Fundus photo; 848x848; 45° field of view; camera: NIDEK AFC-230; diabetic retinopathy graded by the modified Davis classification; no pharmacologic dilation: 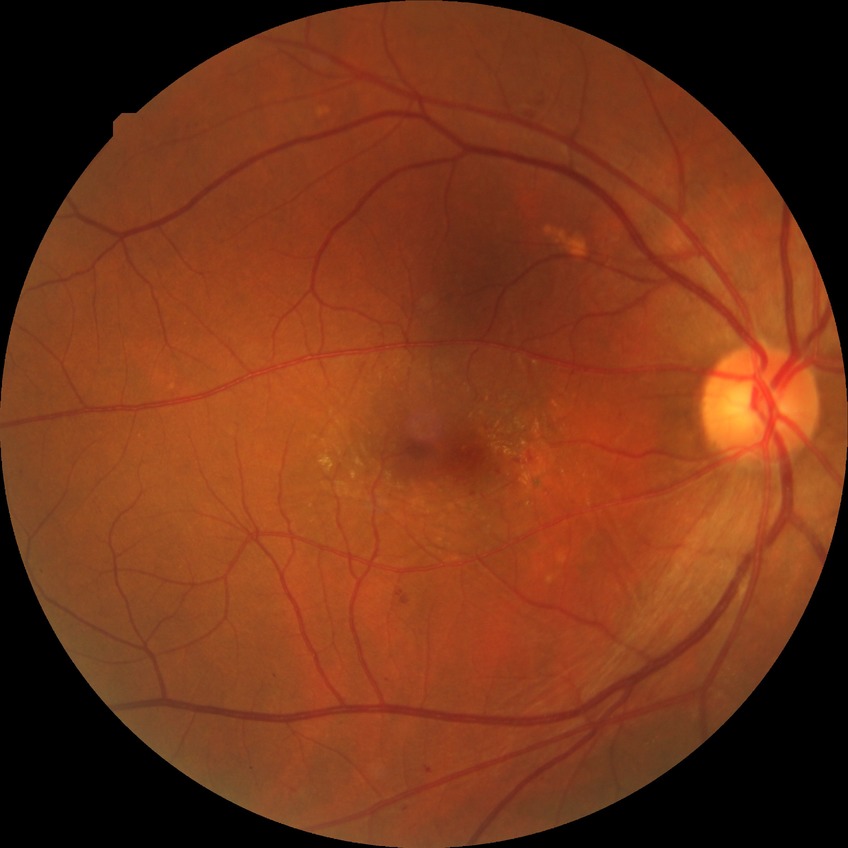 Diabetic retinopathy (DR) is simple diabetic retinopathy (SDR).